Camera: NIDEK AFC-230.
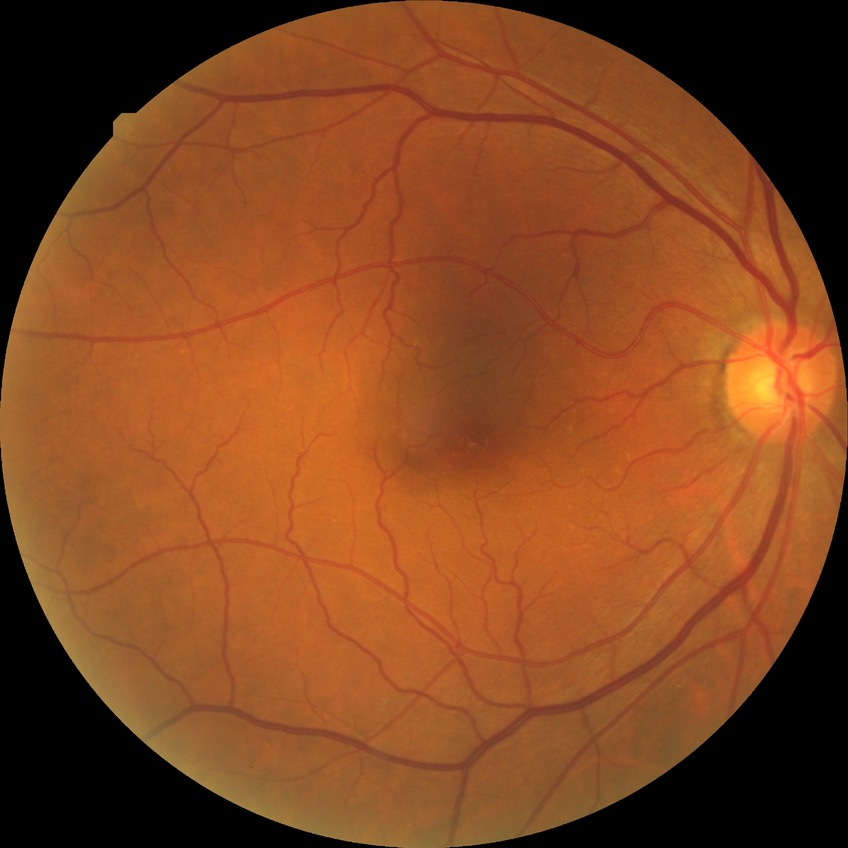

Findings:
- DR — NDR